RetCam wide-field infant fundus image. Clarity RetCam 3, 130° FOV. 640 by 480 pixels.
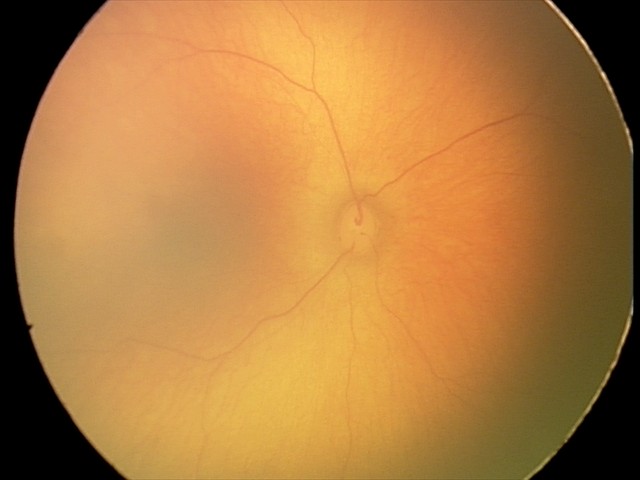 Diagnosis: no abnormalities.